CFP.
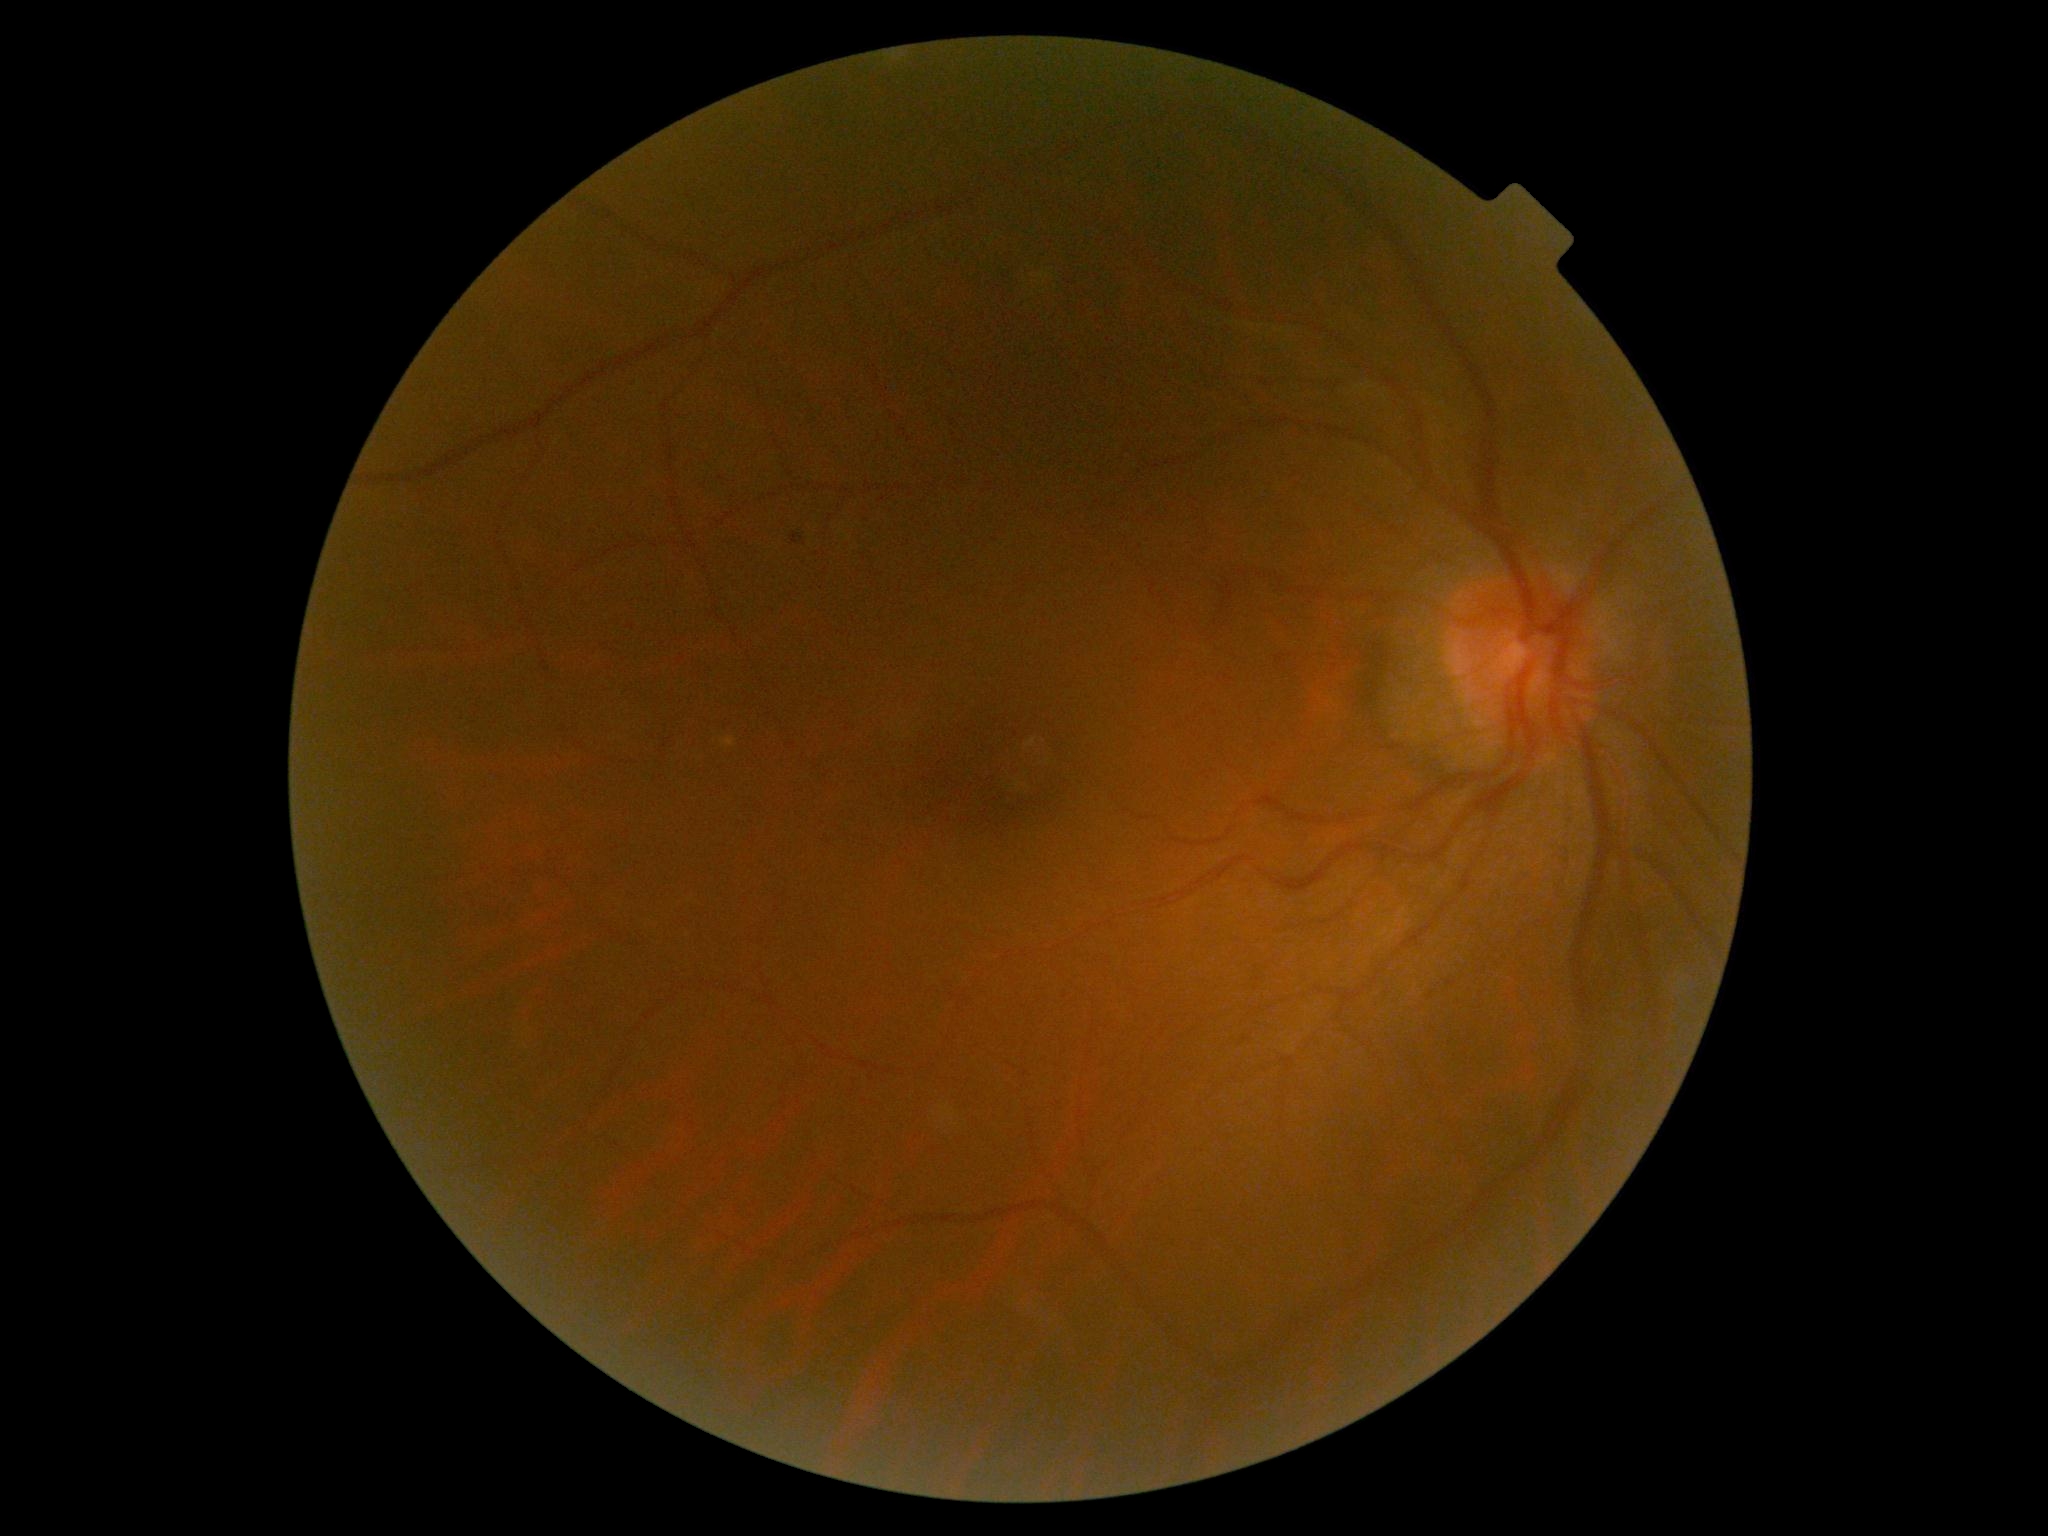

DR is moderate non-proliferative diabetic retinopathy (grade 2) — more than just microaneurysms but less than severe NPDR.